Retinal fundus photograph; 45° FOV; 1380x1382px.
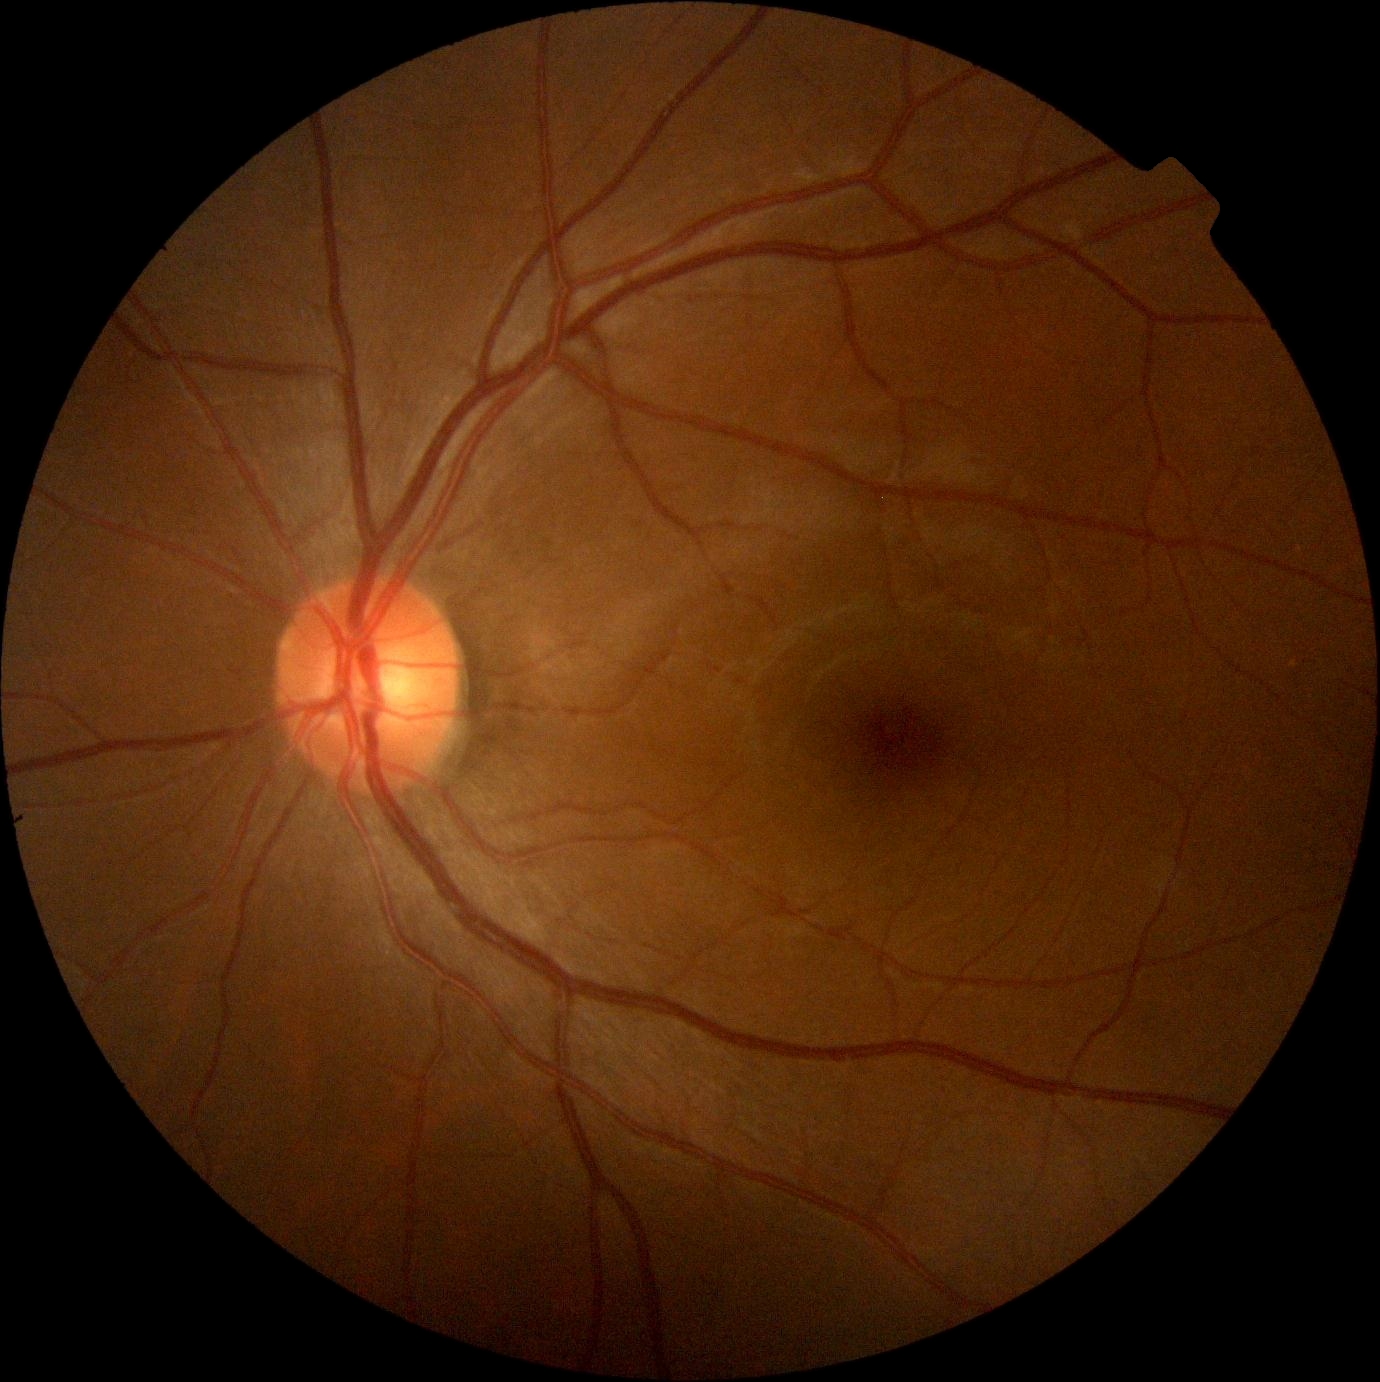 Diabetic retinopathy (DR): 0/4.